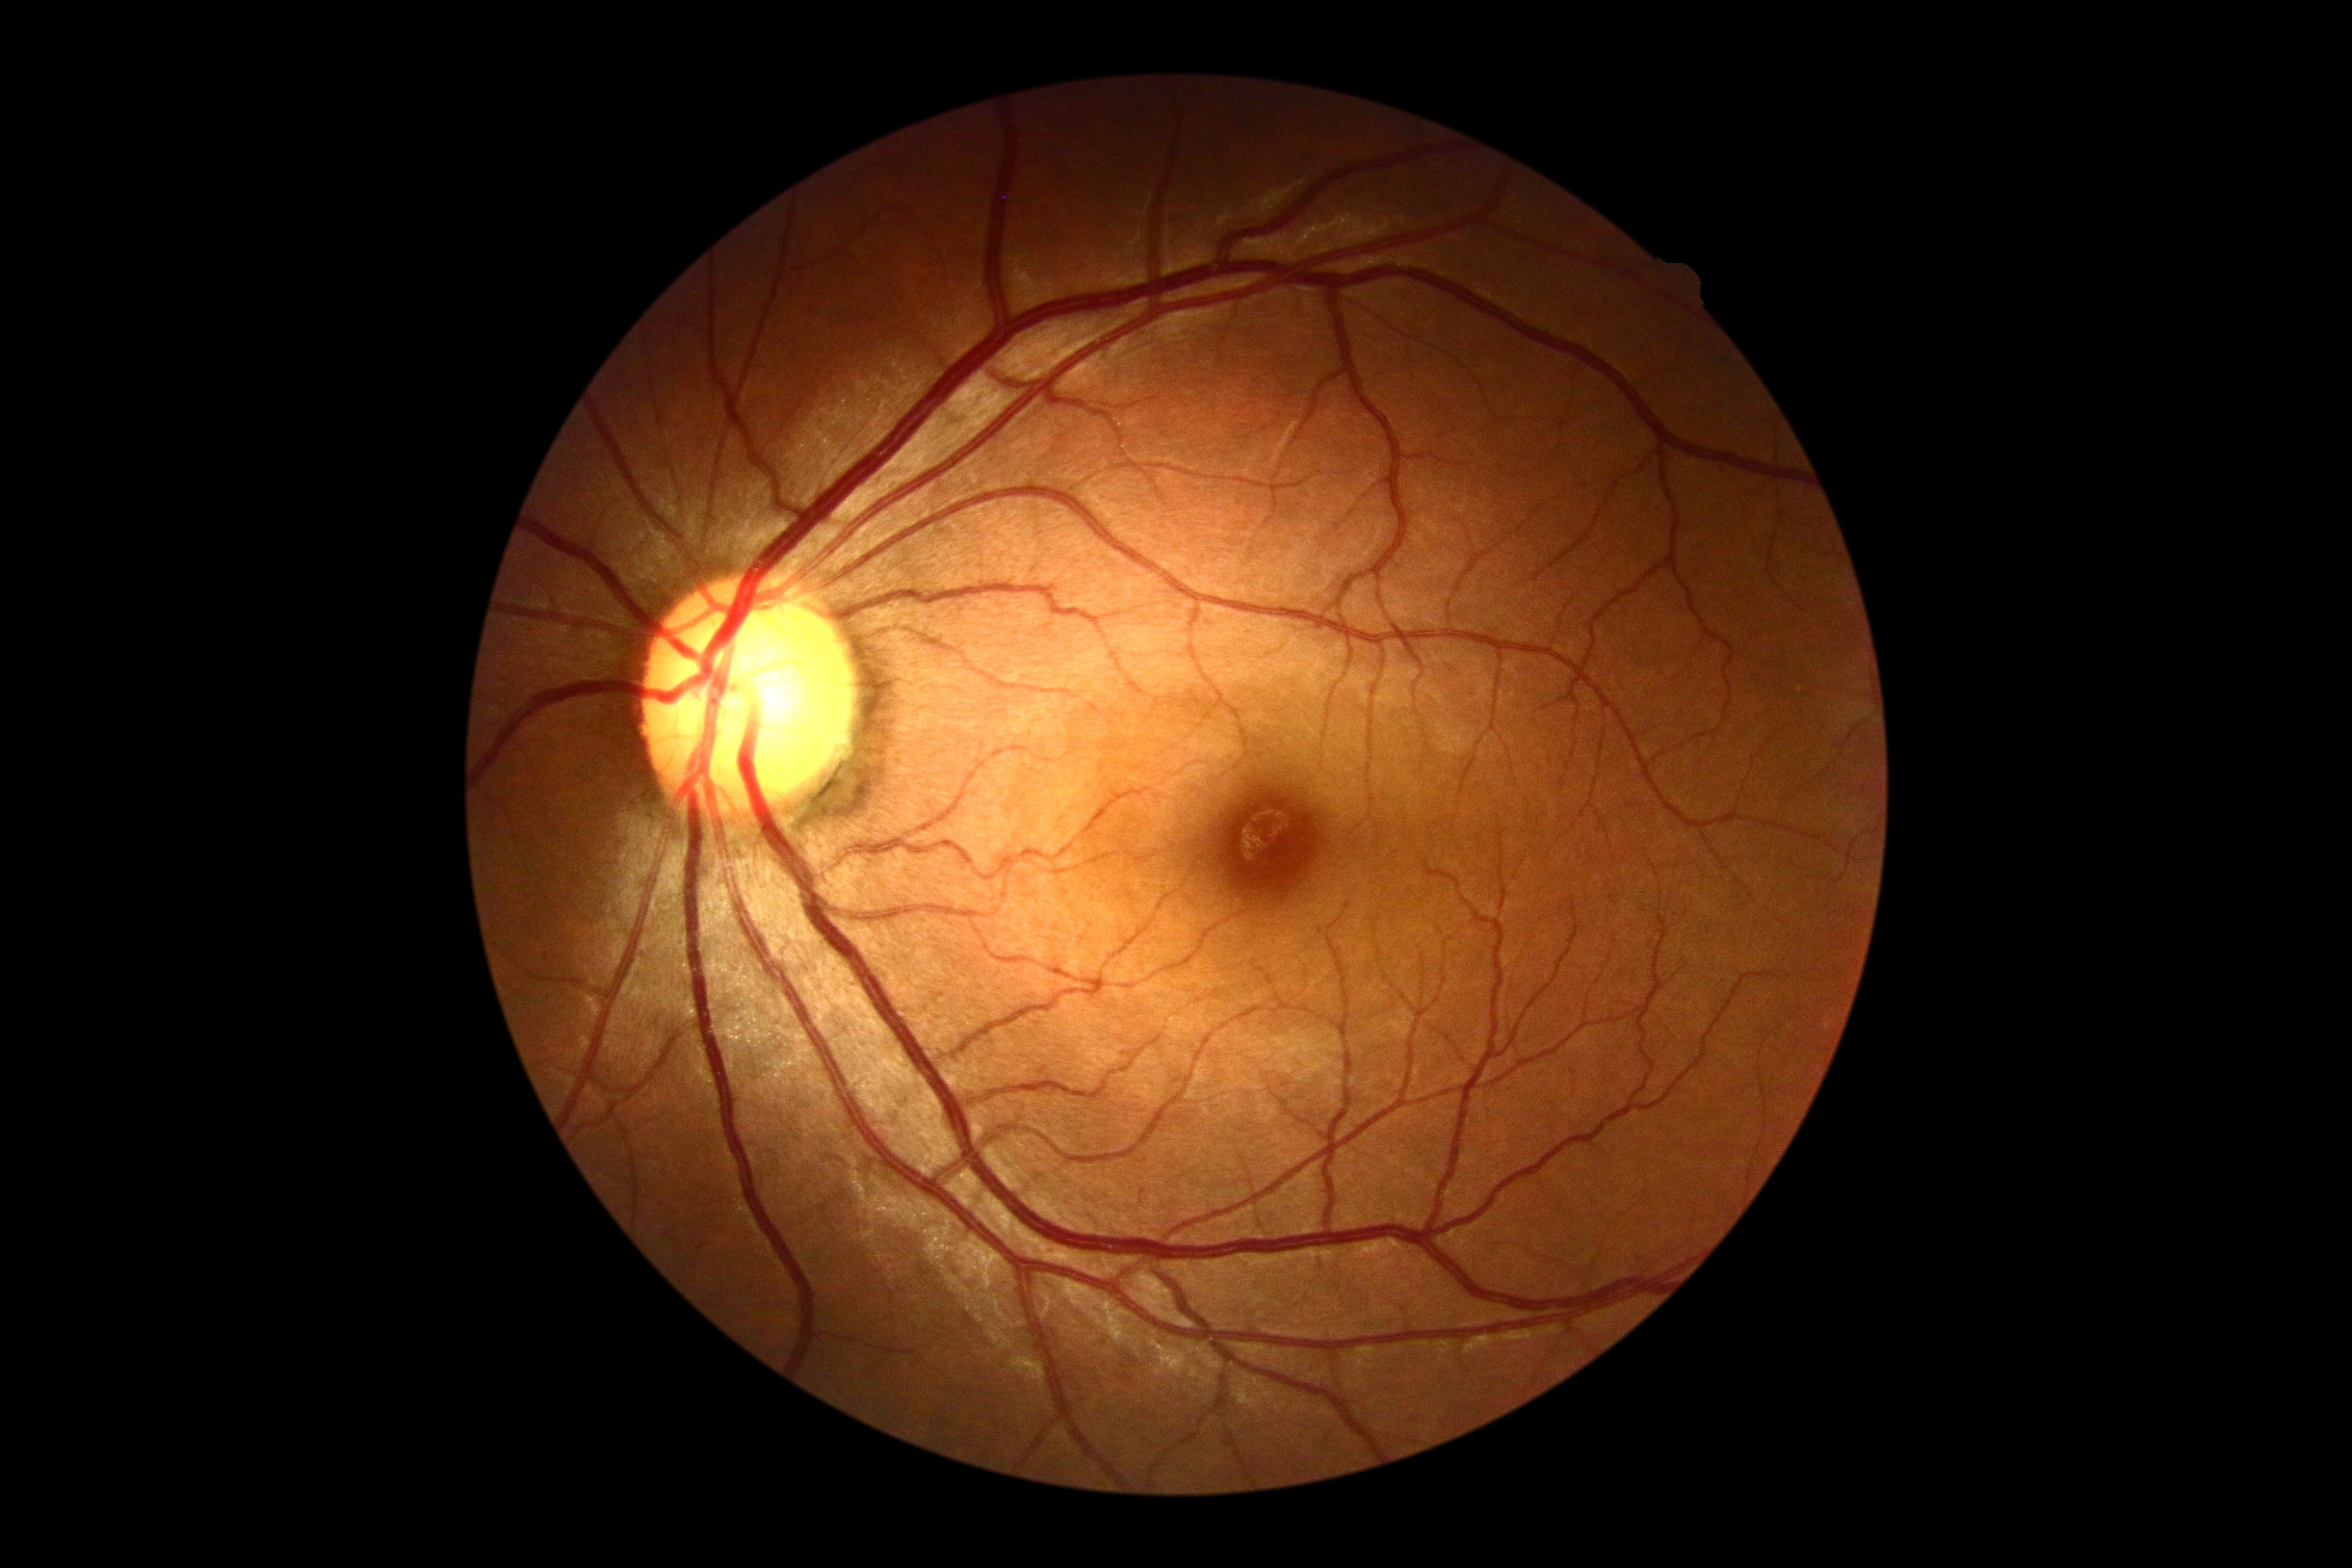
  dr_grade: 0 (no apparent retinopathy)